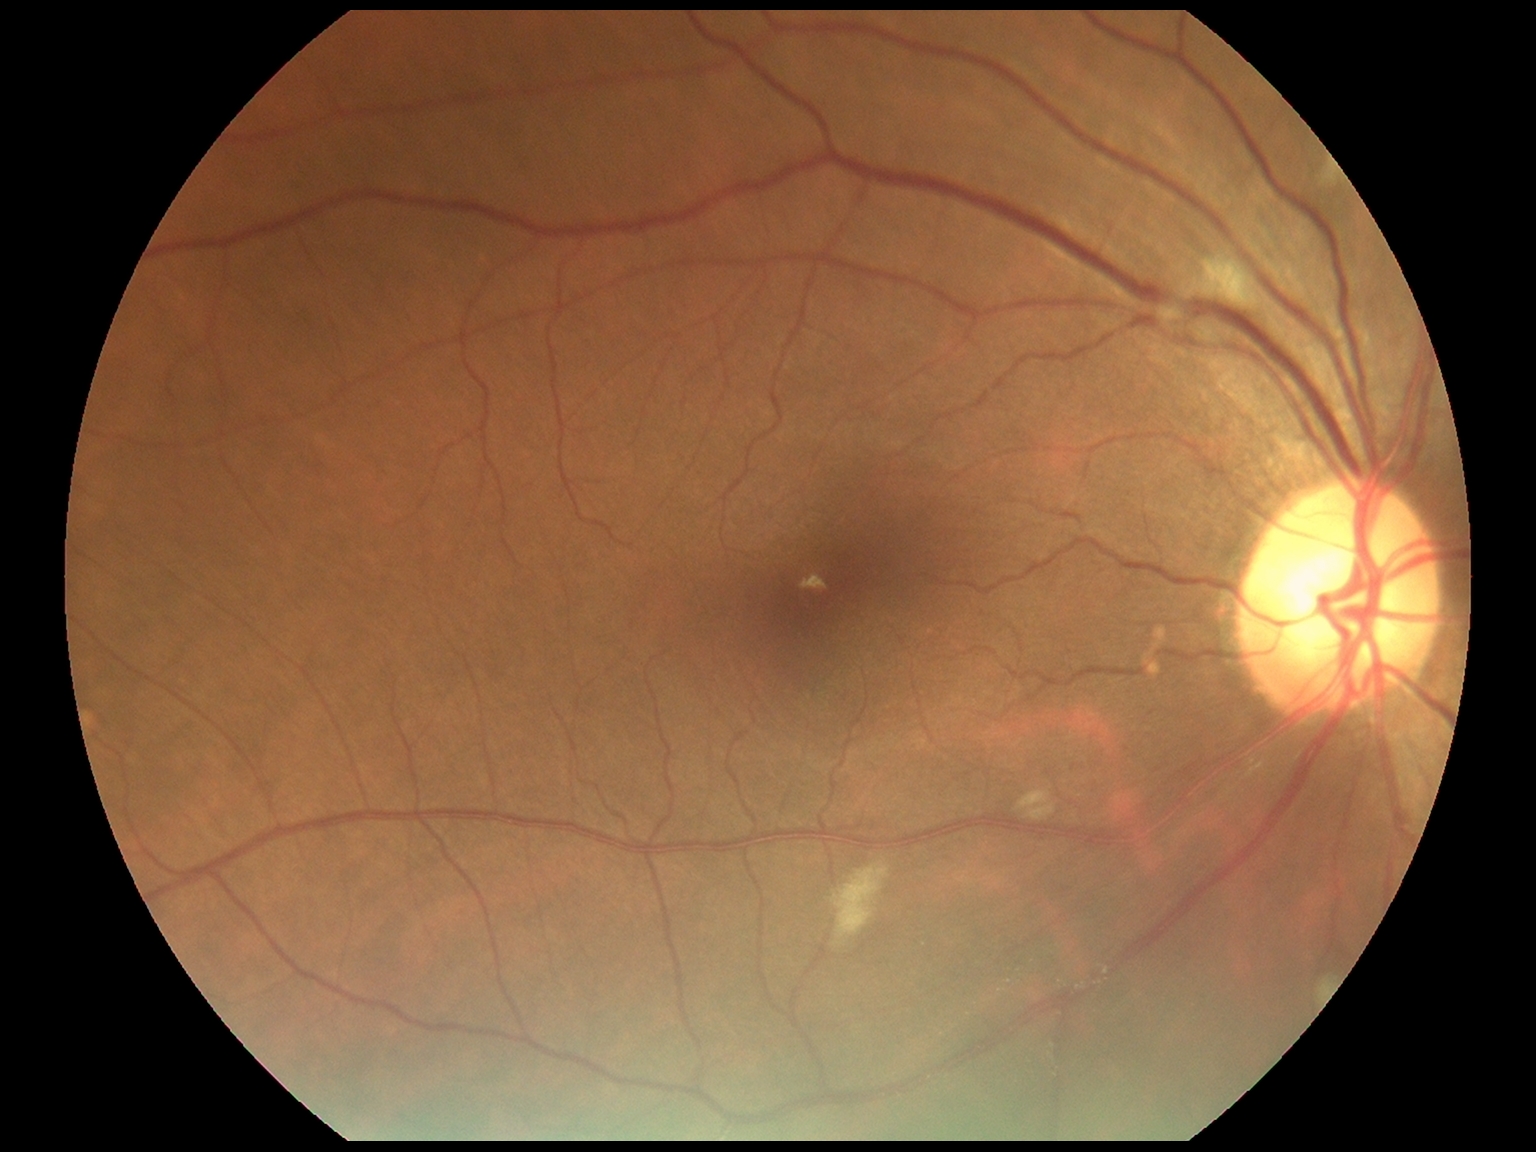
Diabetic retinopathy severity is grade 2.